FOV: 45 degrees — 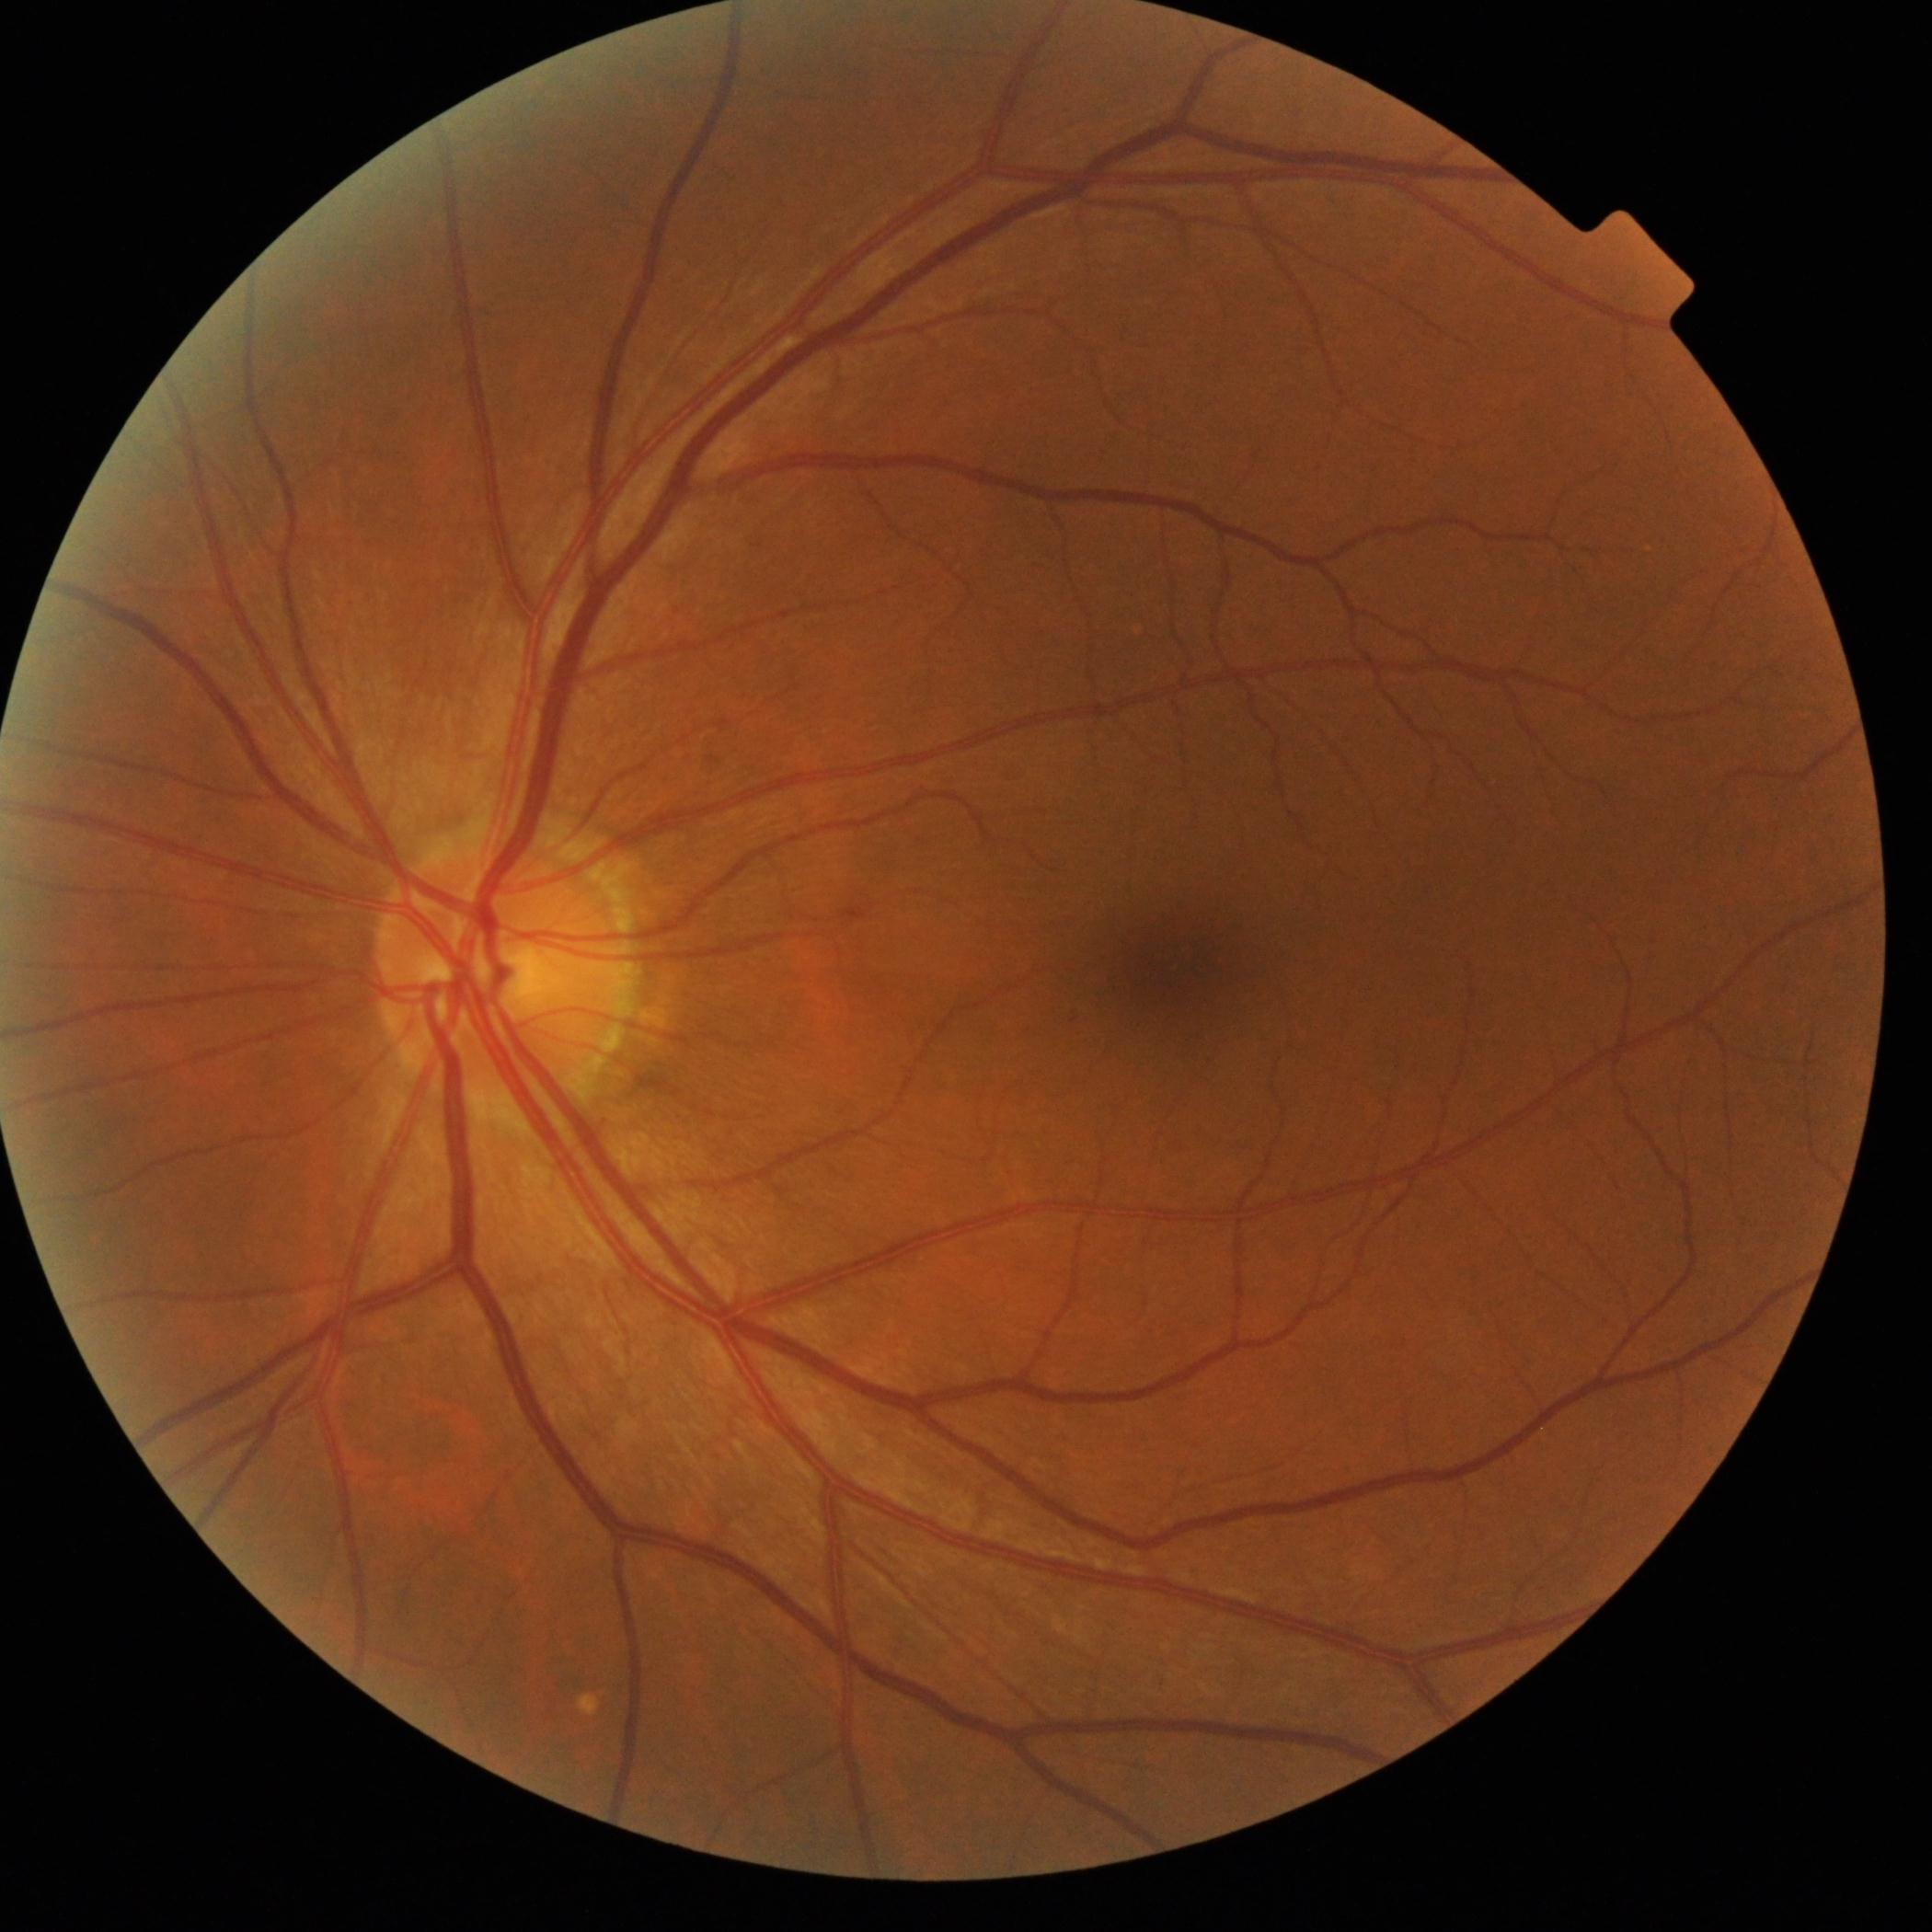
DR is 0.